45° field of view:
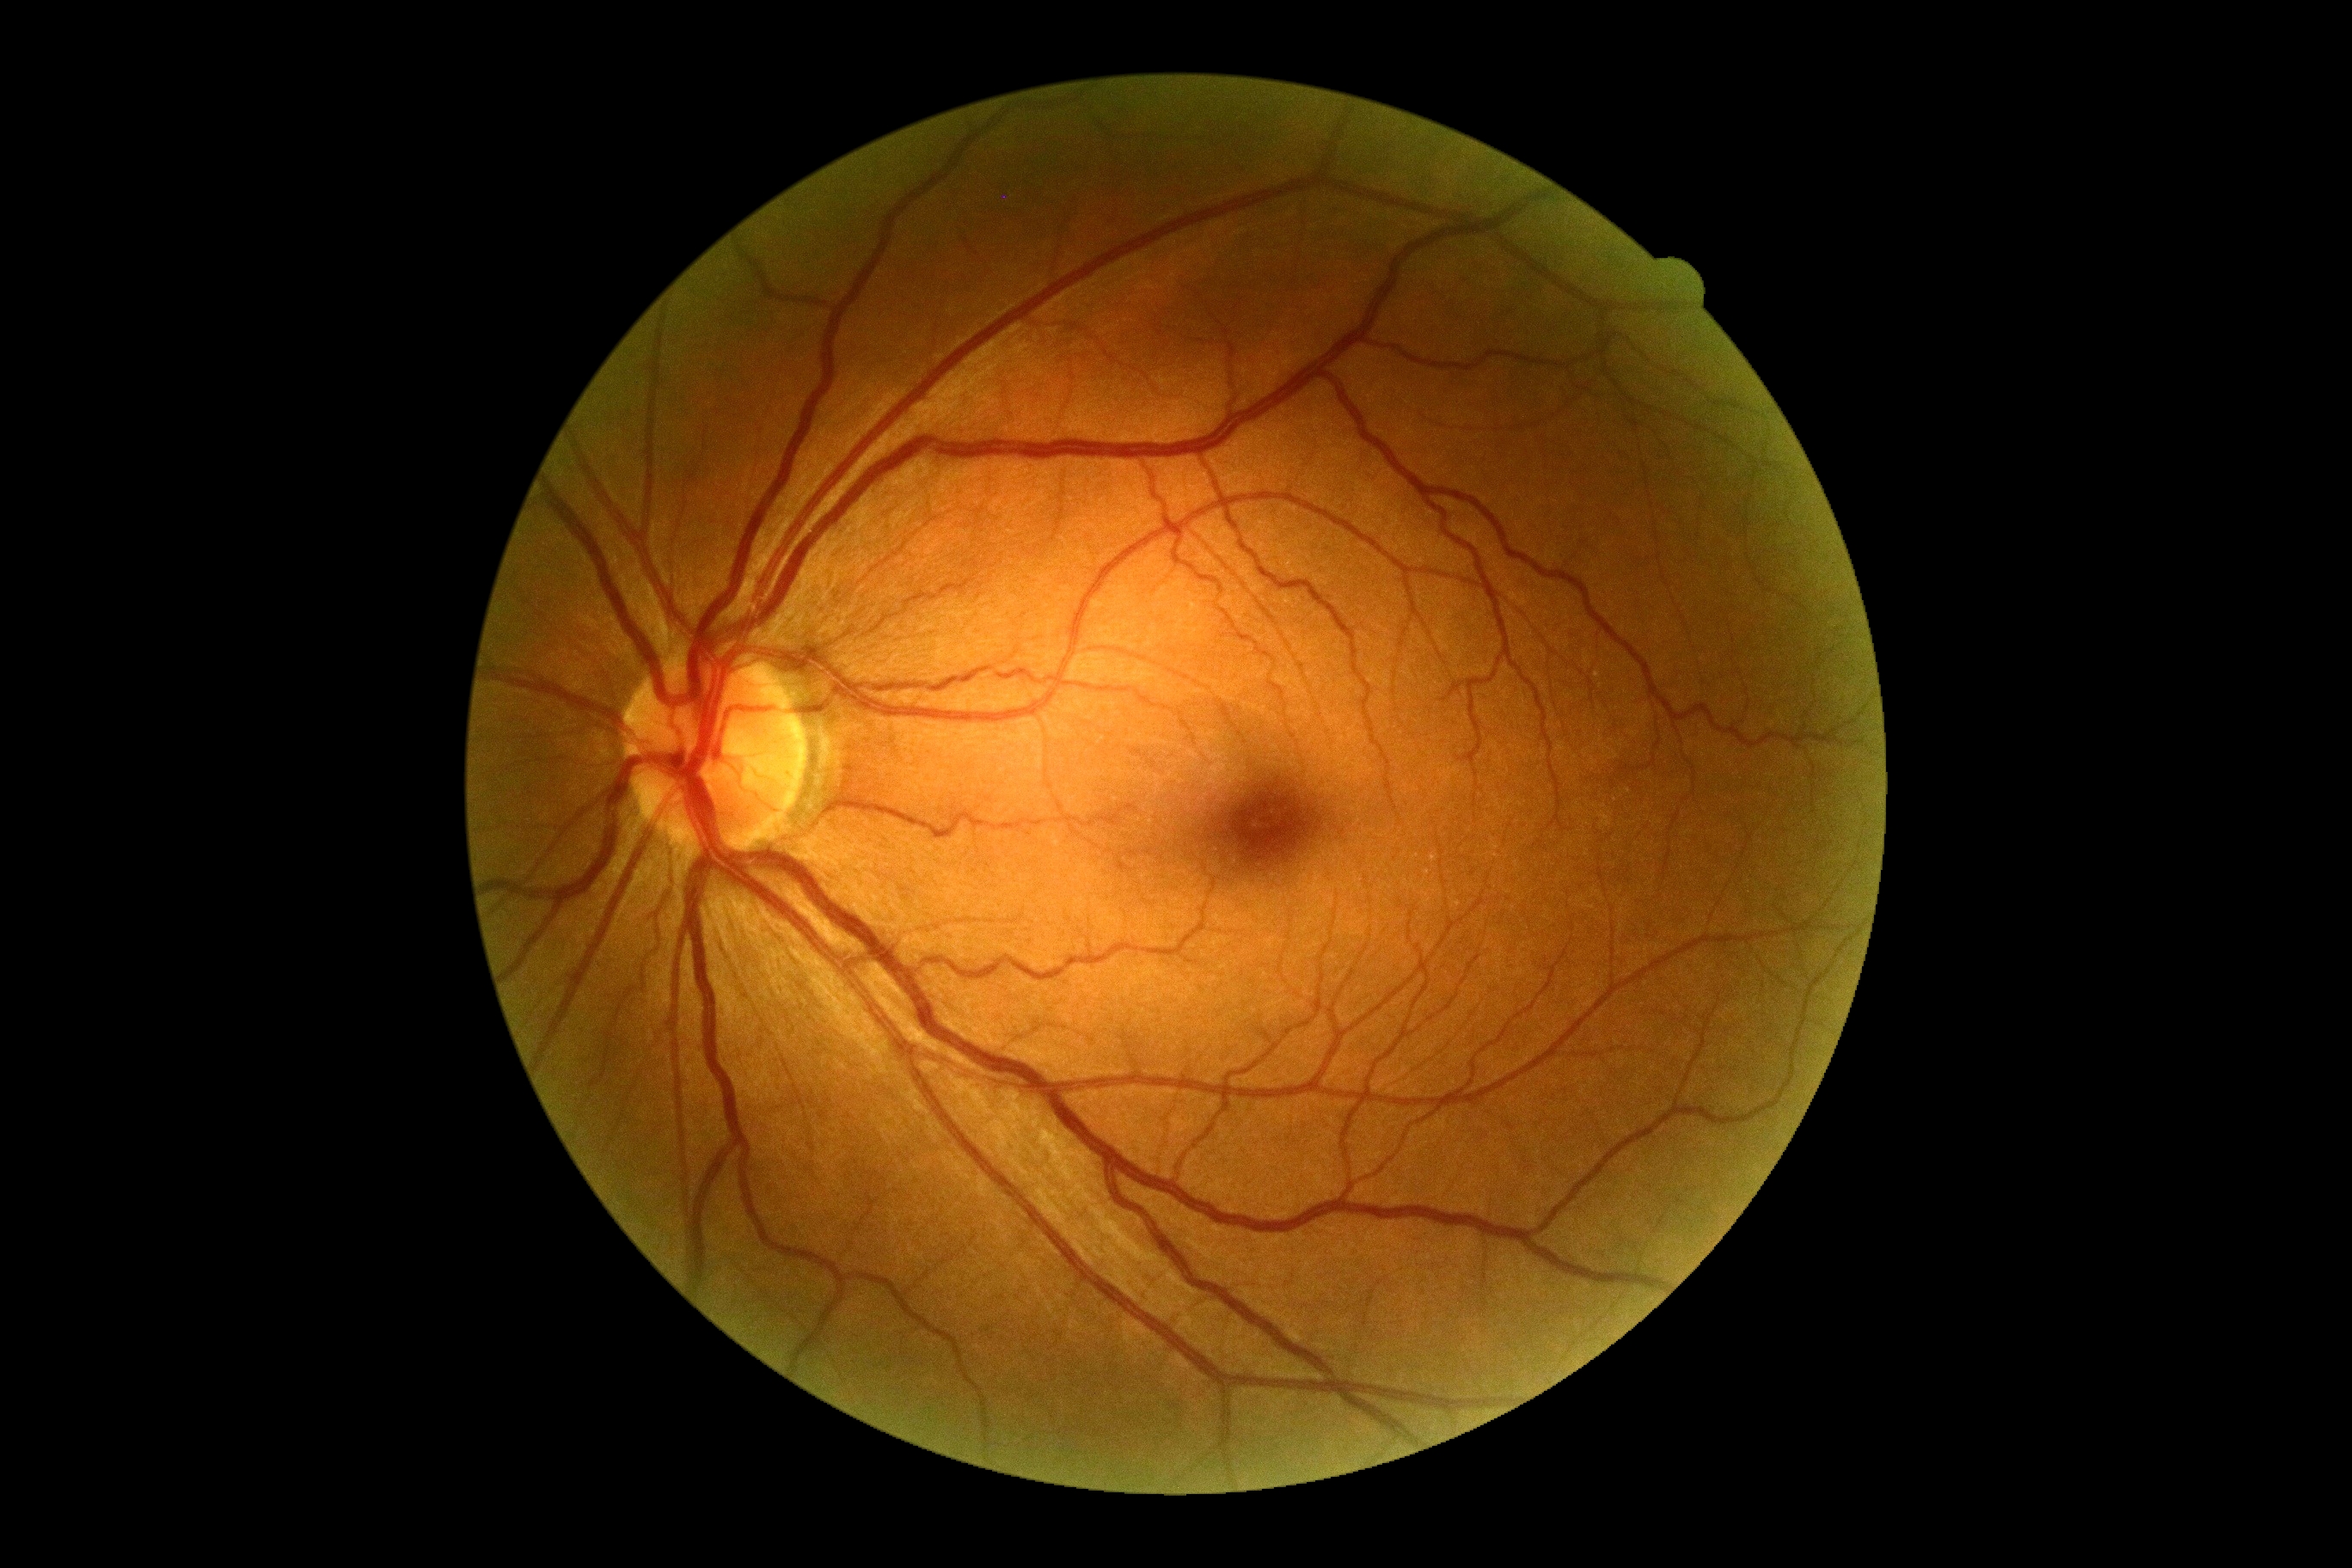

DR stage: 0.